FOV: 50 degrees · fundus photo · 2228 x 1652 pixels.
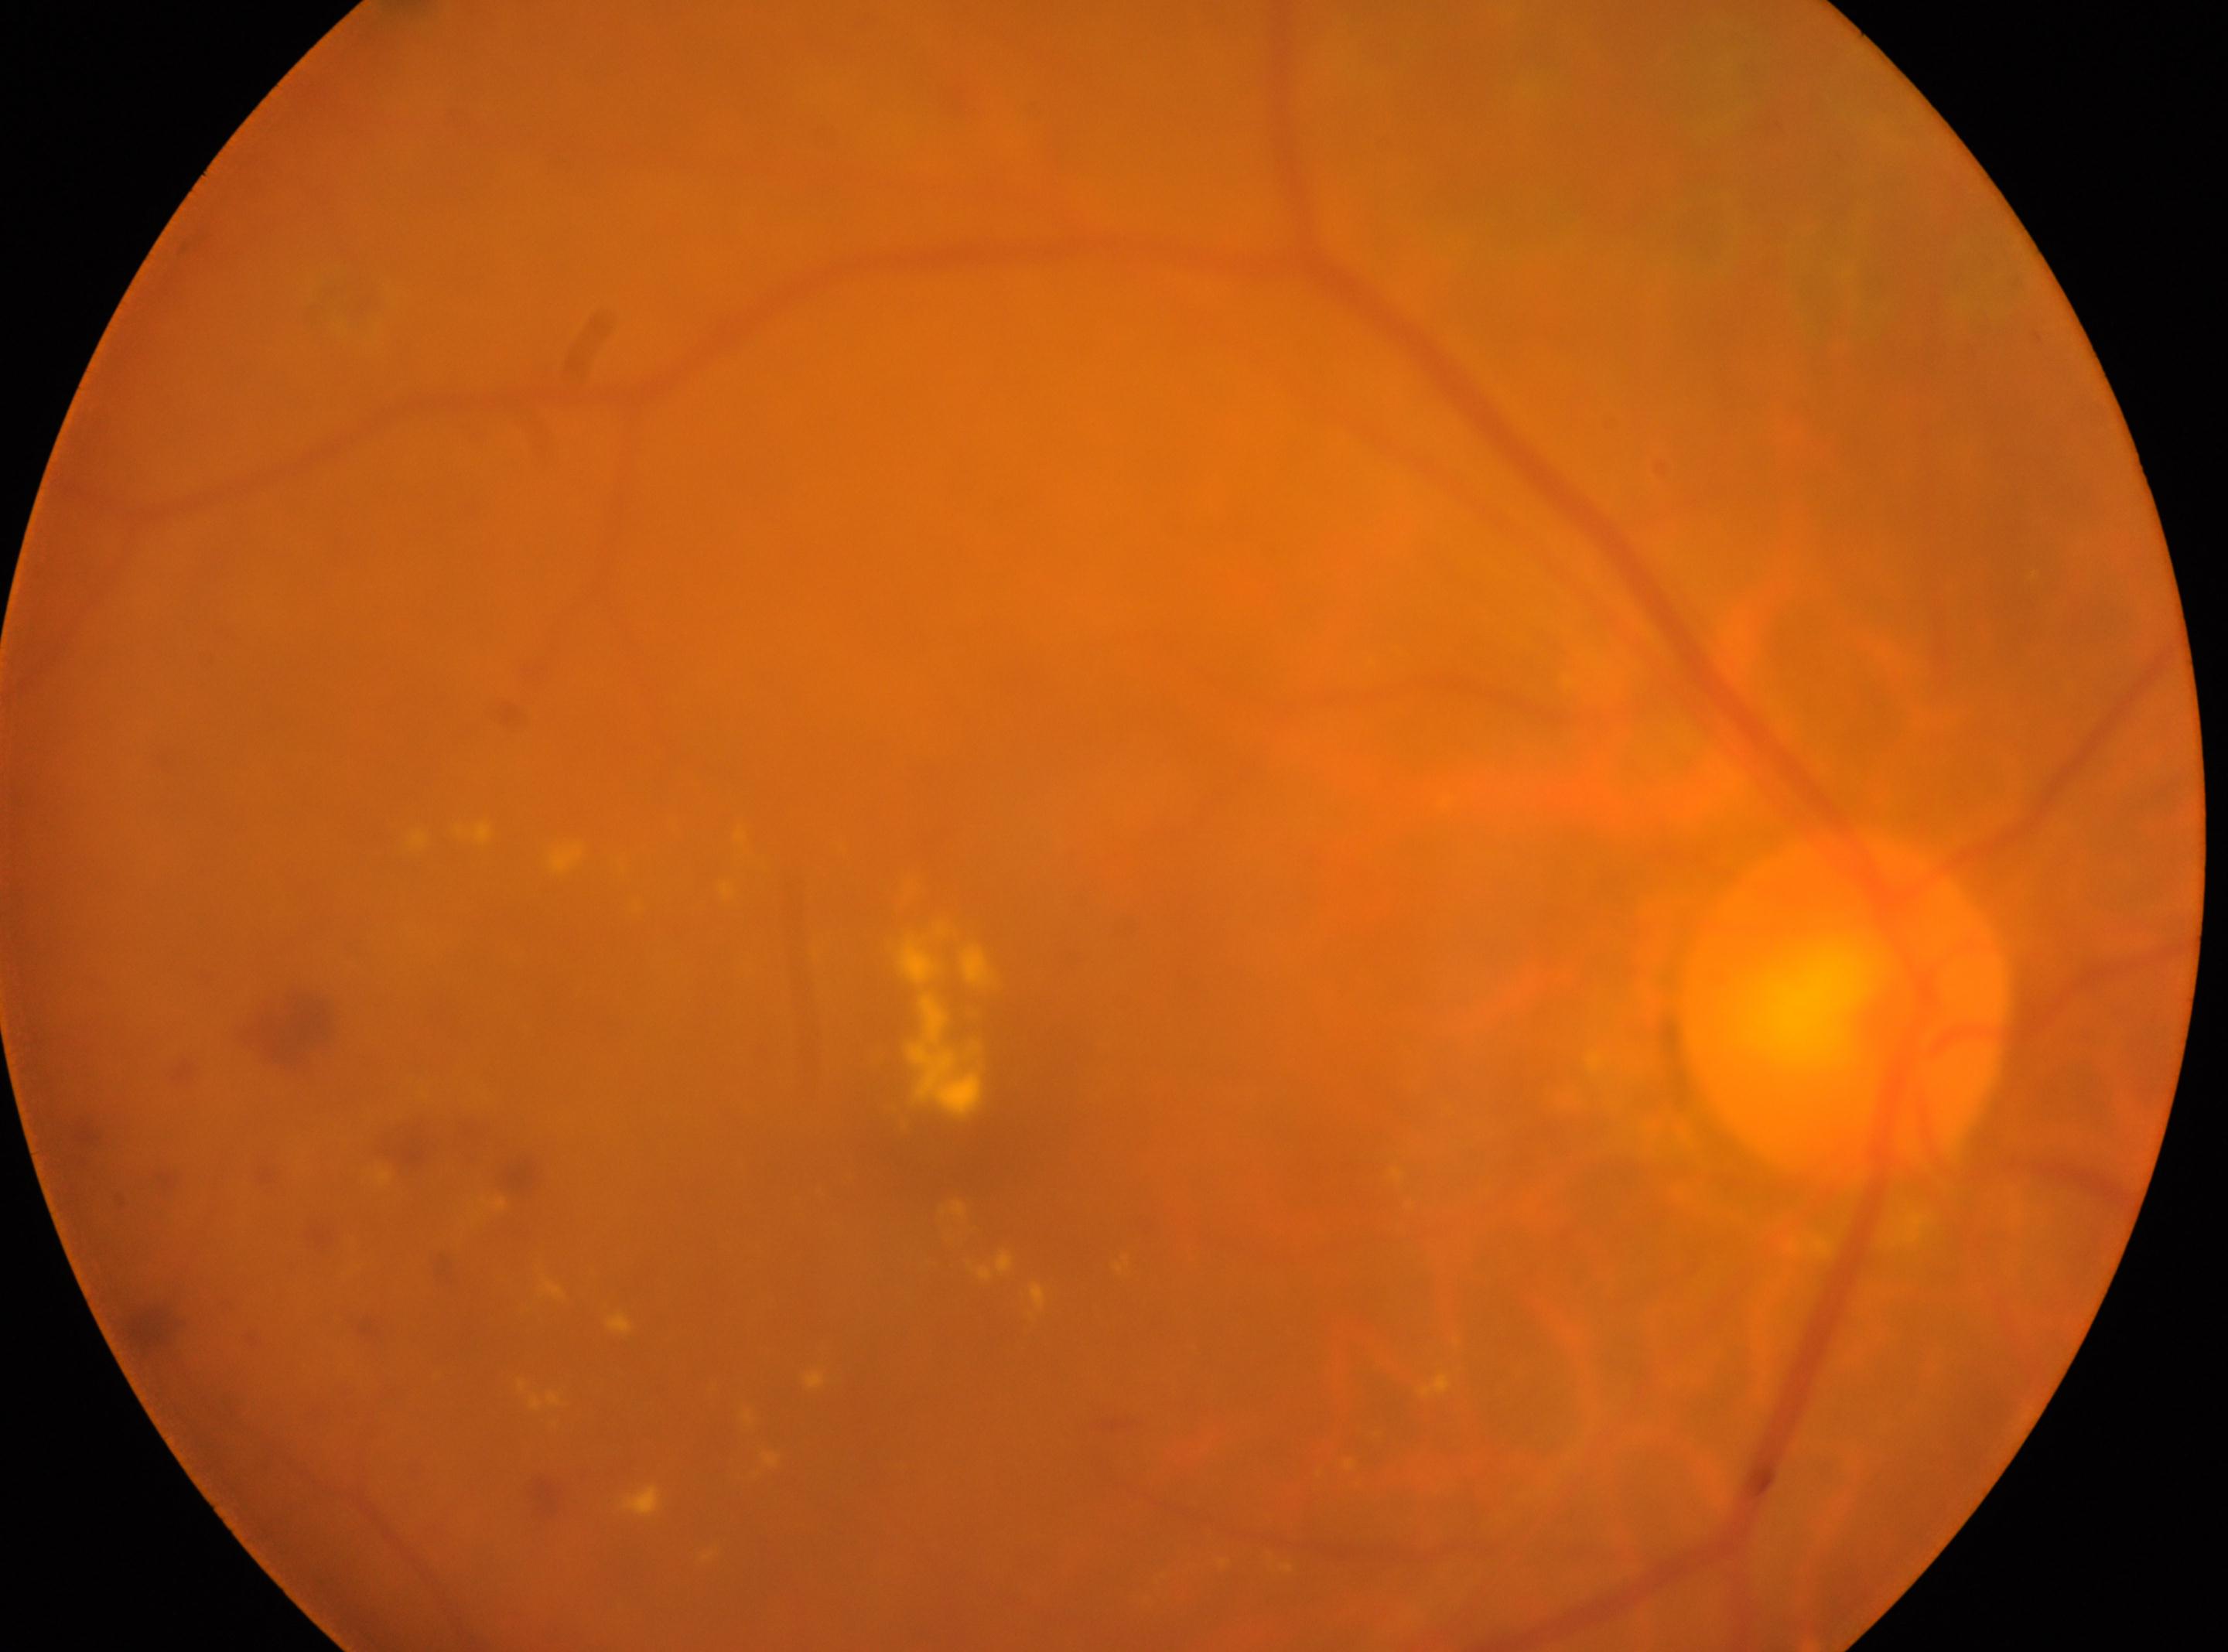

This is the right eye. Optic disc: (x: 1844, y: 1007). Macular center located at (x: 967, y: 1155). Diabetic retinopathy grade is moderate non-proliferative diabetic retinopathy (2).